NIDEK AFC-230 fundus camera; 45-degree field of view — 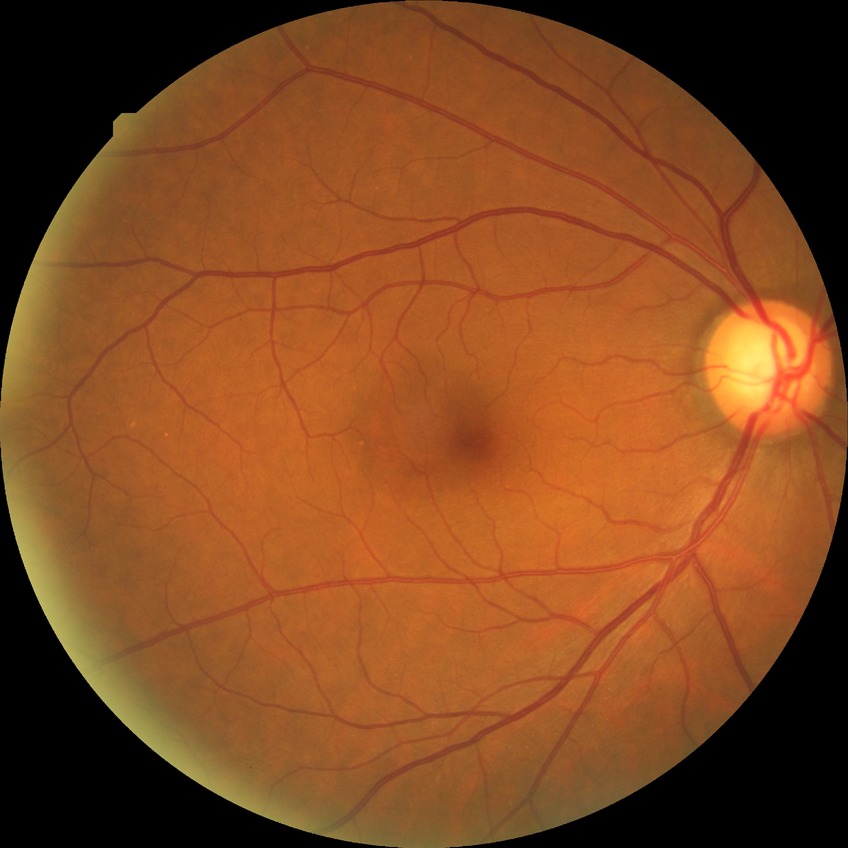

Diabetic retinopathy (DR) is NDR (no diabetic retinopathy).